Portable fundus photograph.
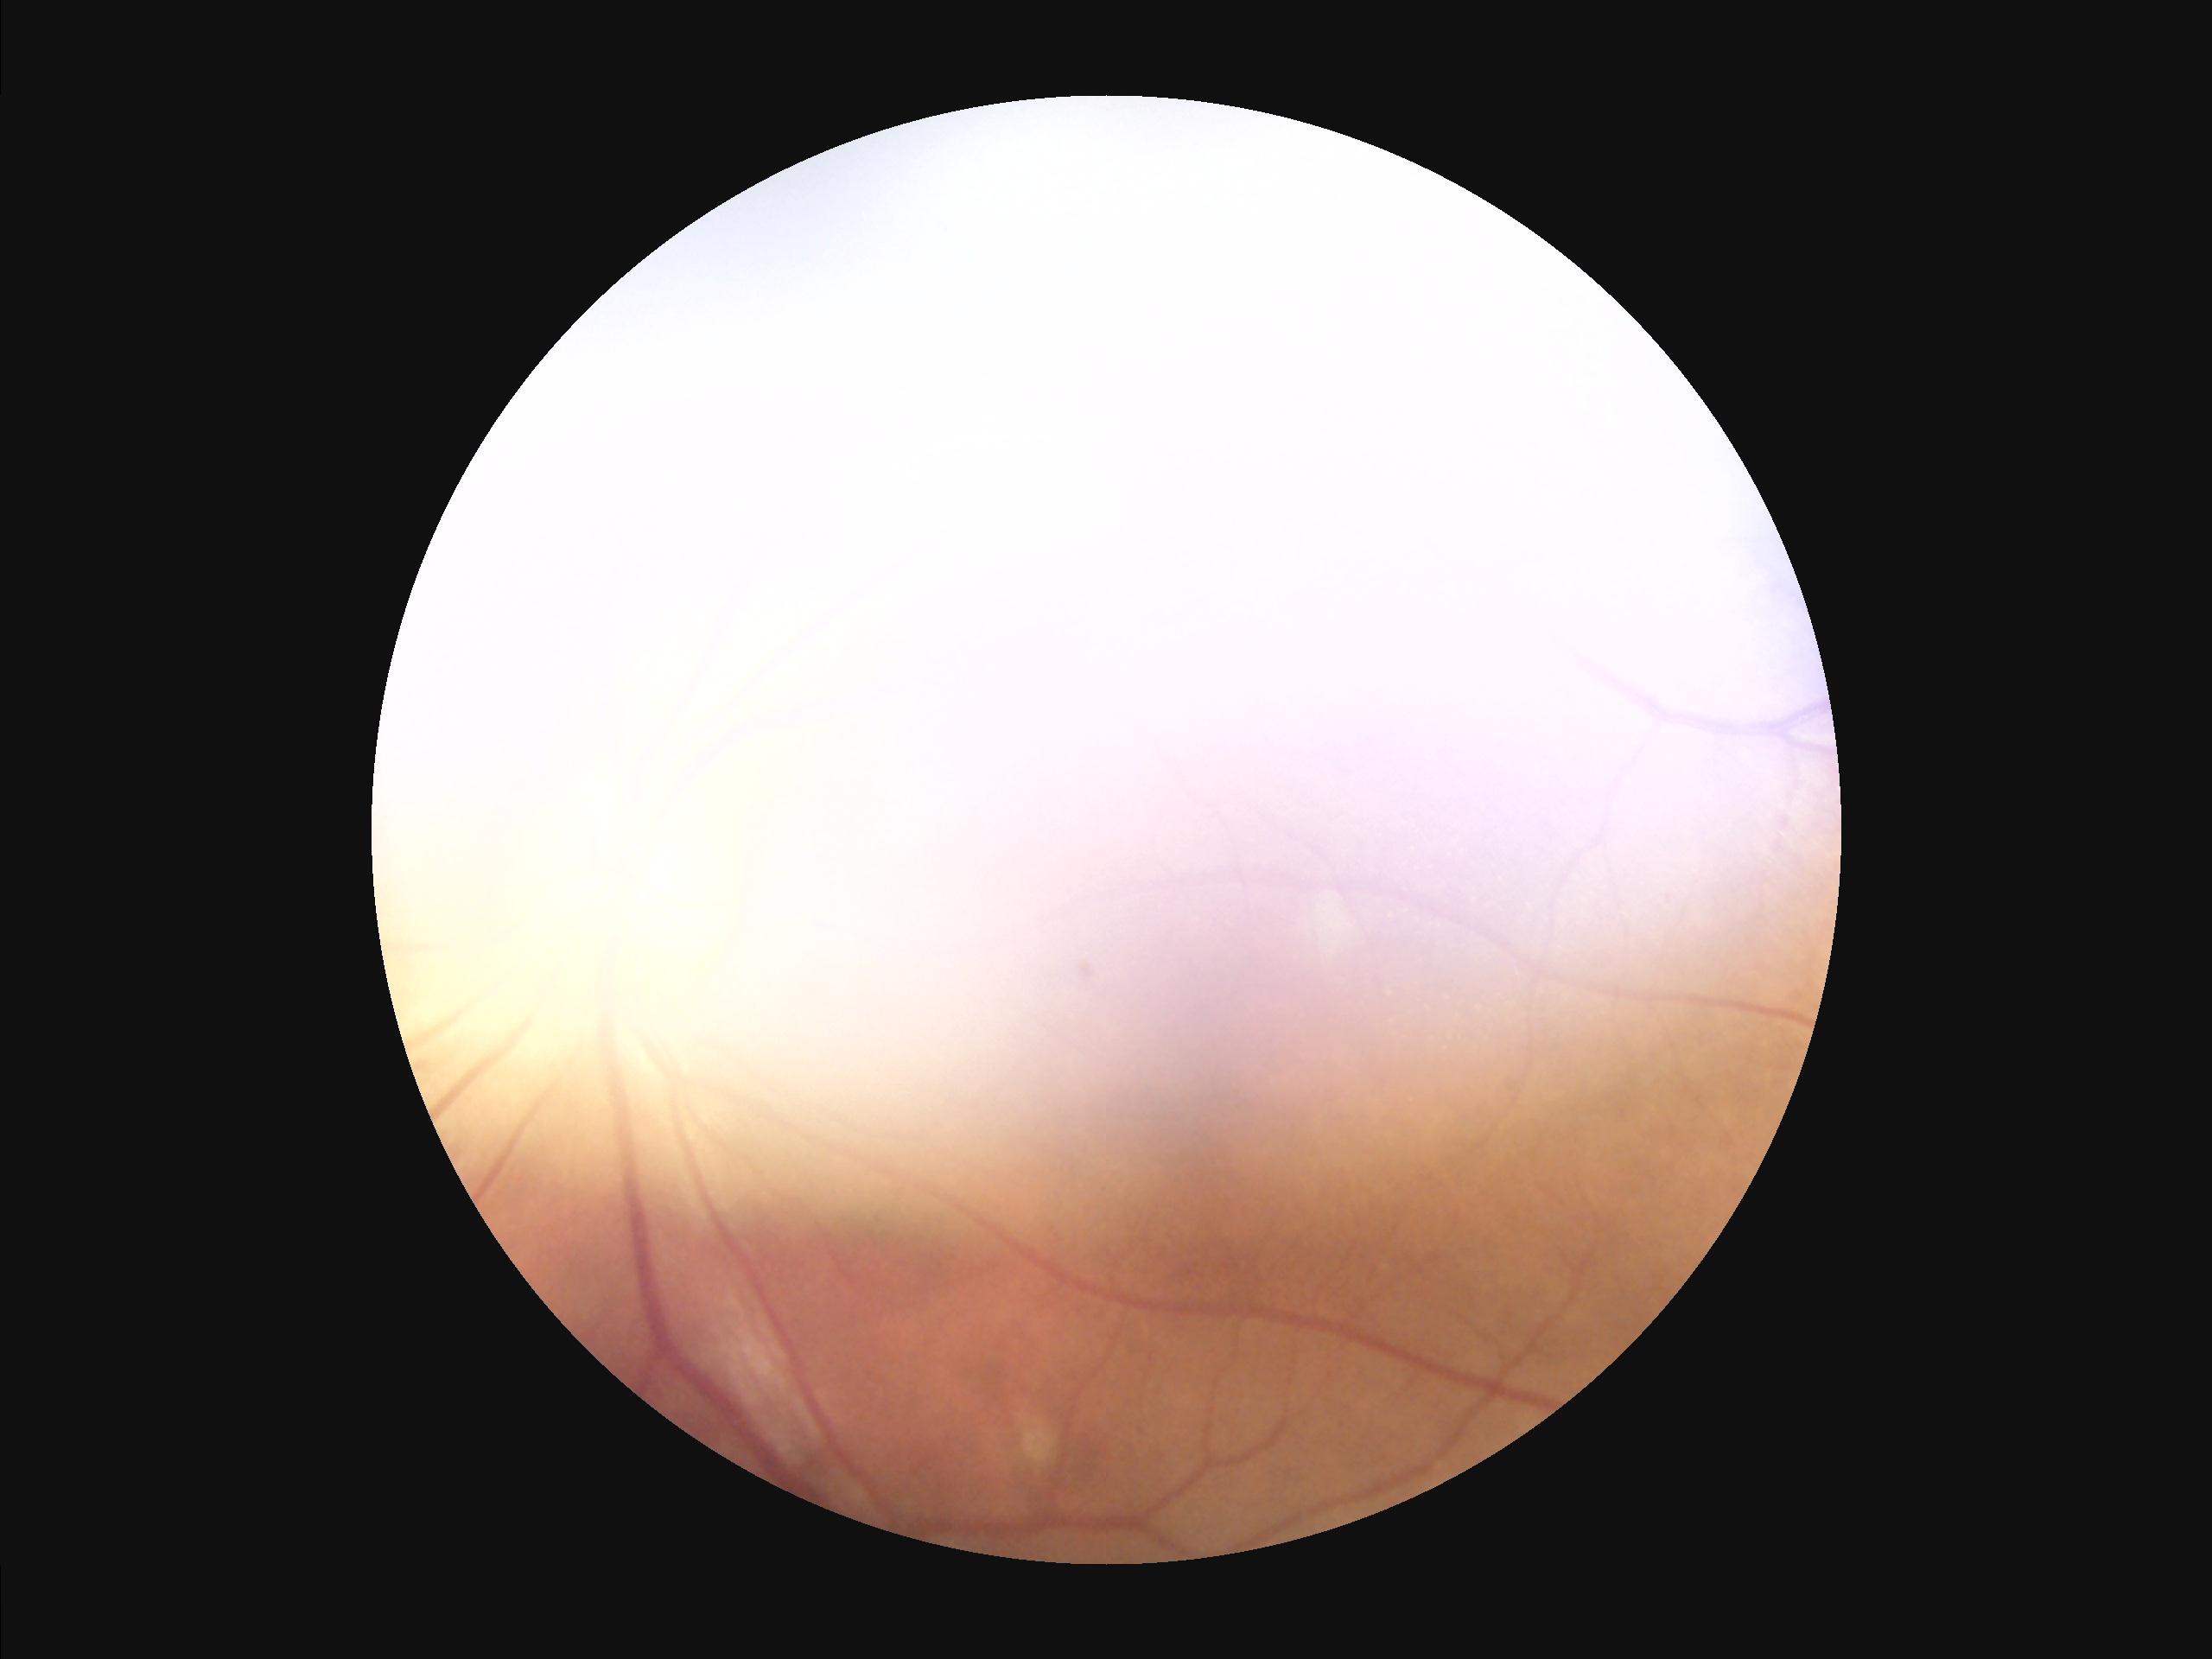
Quality grading: contrast: low, vessels and details hard to distinguish; focus: noticeable blur in the optic disc, vessels, or background; overall: poor, ungradable; illumination/color: over- or under-exposed.